240x240px — 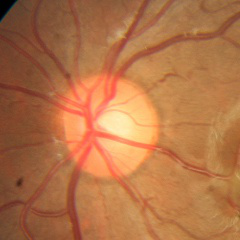 Impression = no evidence of glaucoma.